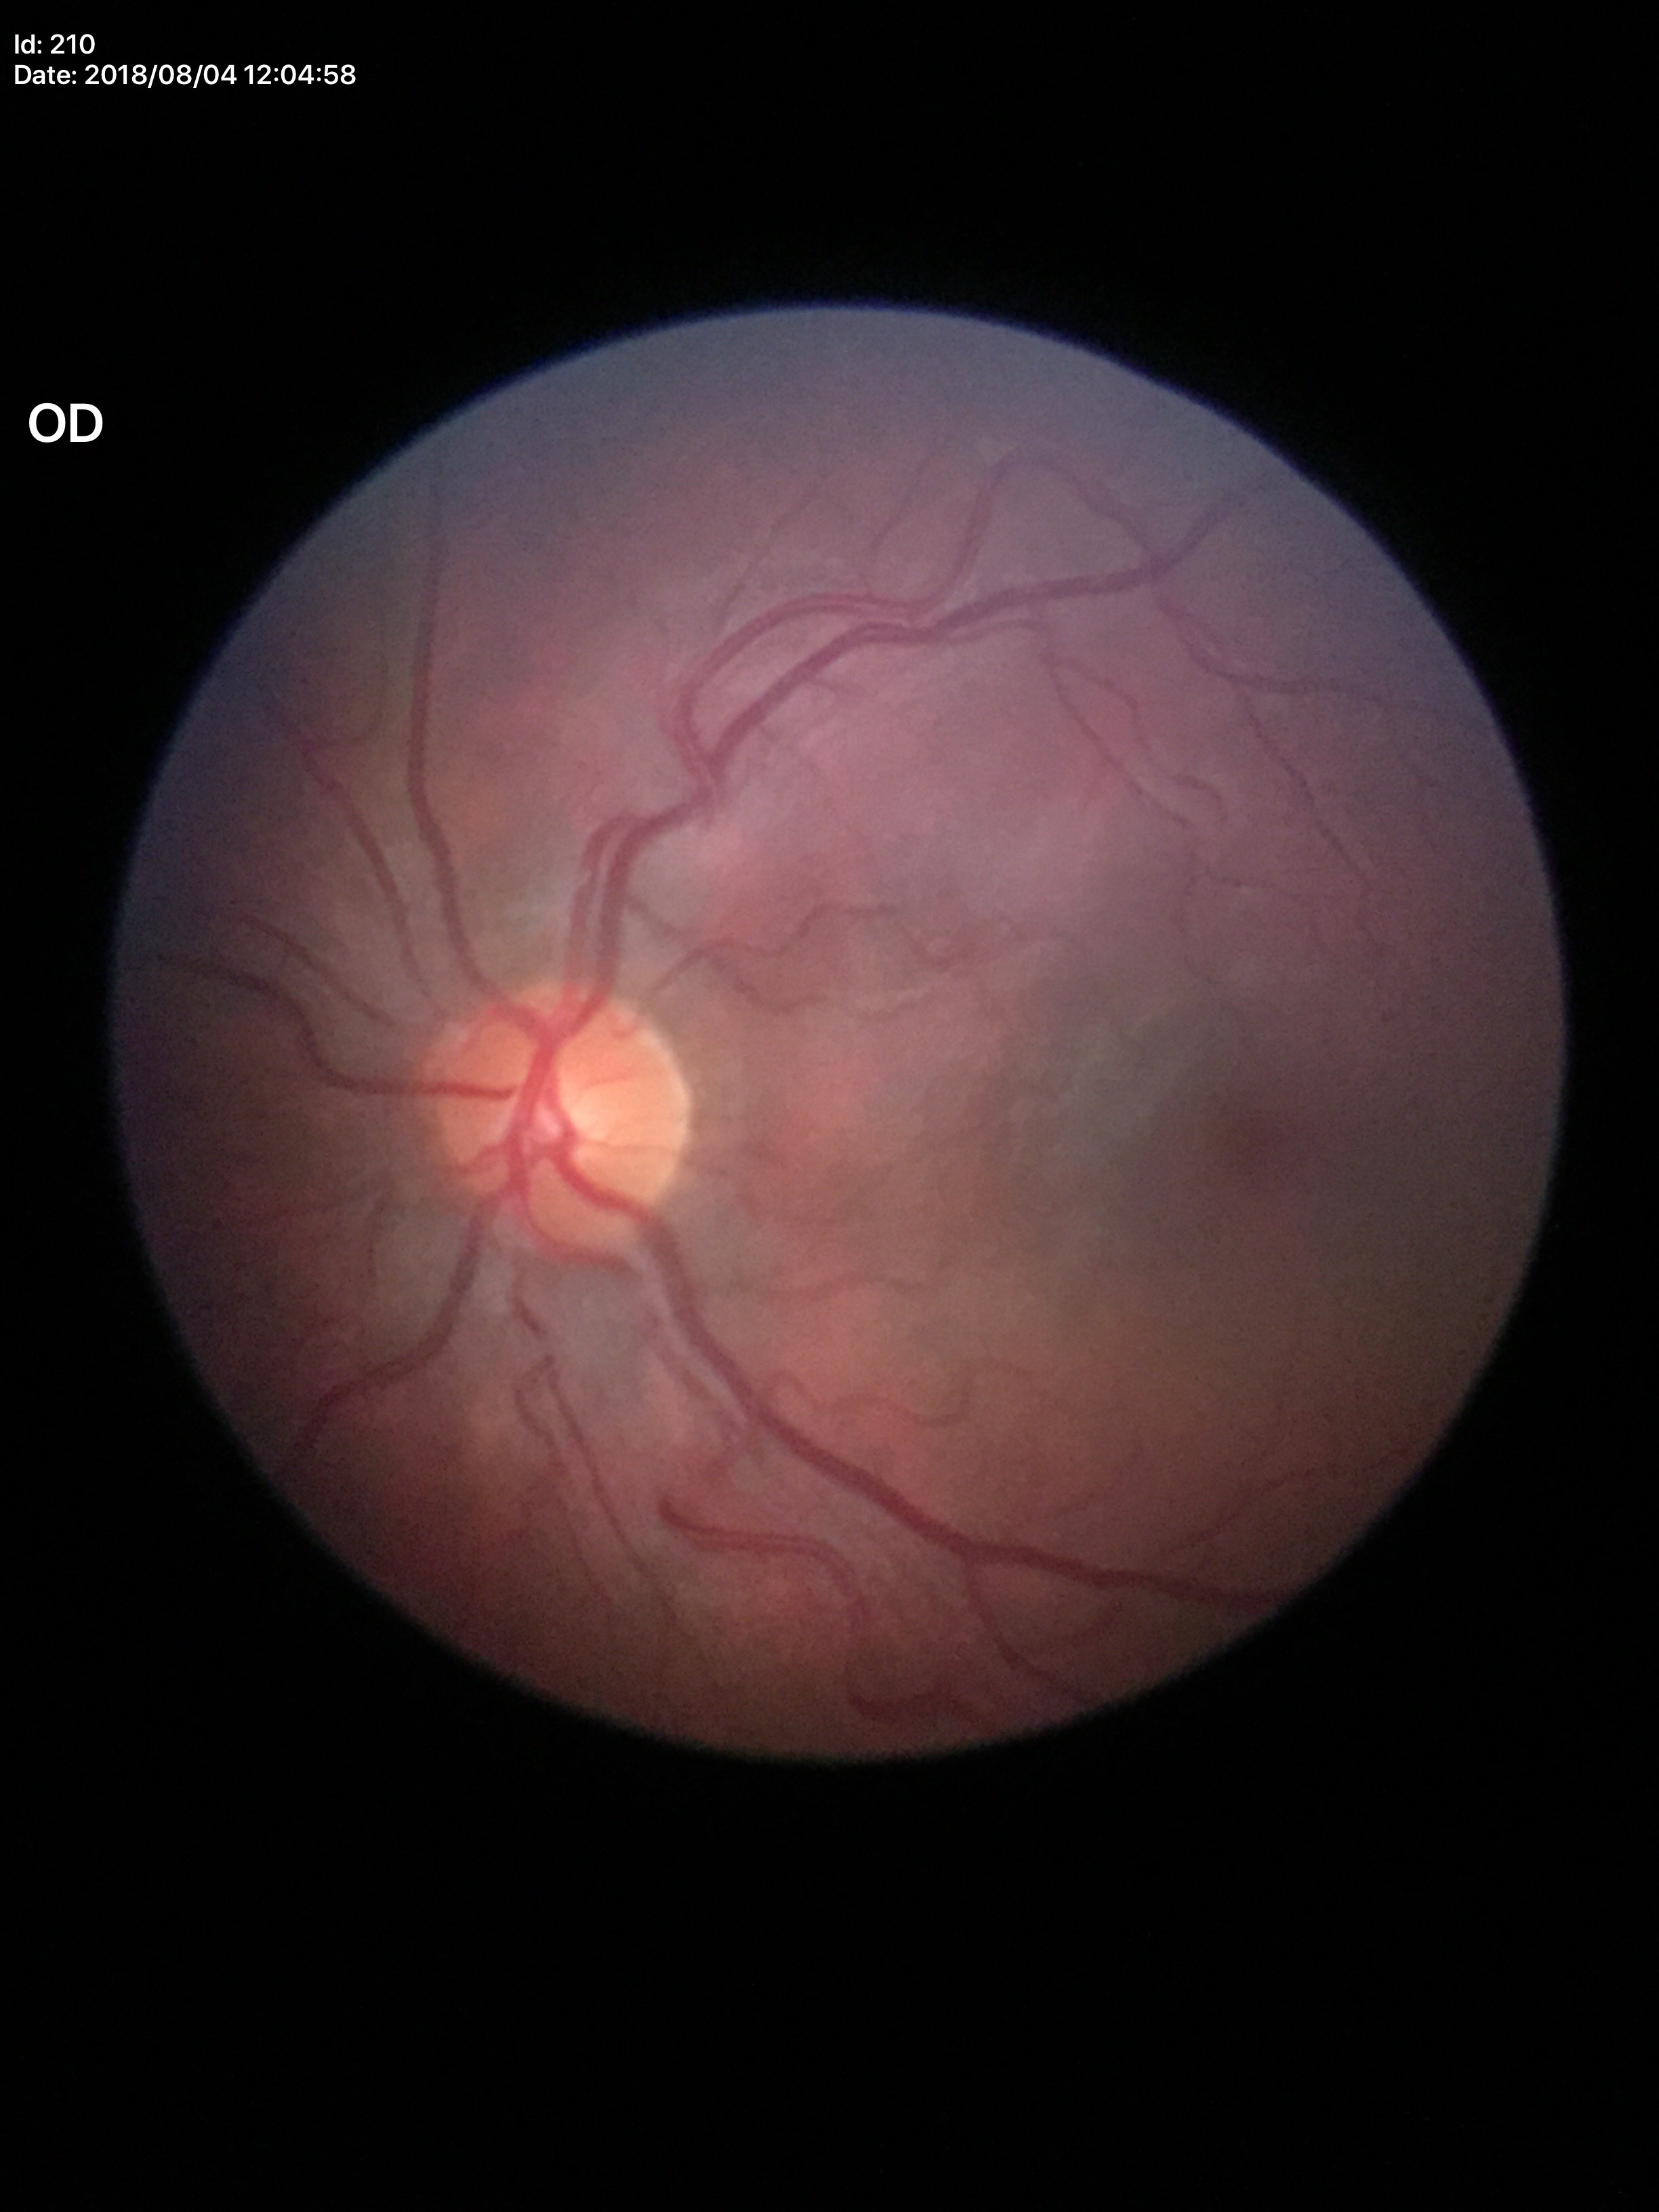 Glaucoma decision: negative (5/5 ophthalmologists in agreement). Horizontal cup-disc ratio (HCDR) of 0.50. Vertical C/D ratio (VCDR) is 0.48.